Topcon TRC-50DX:
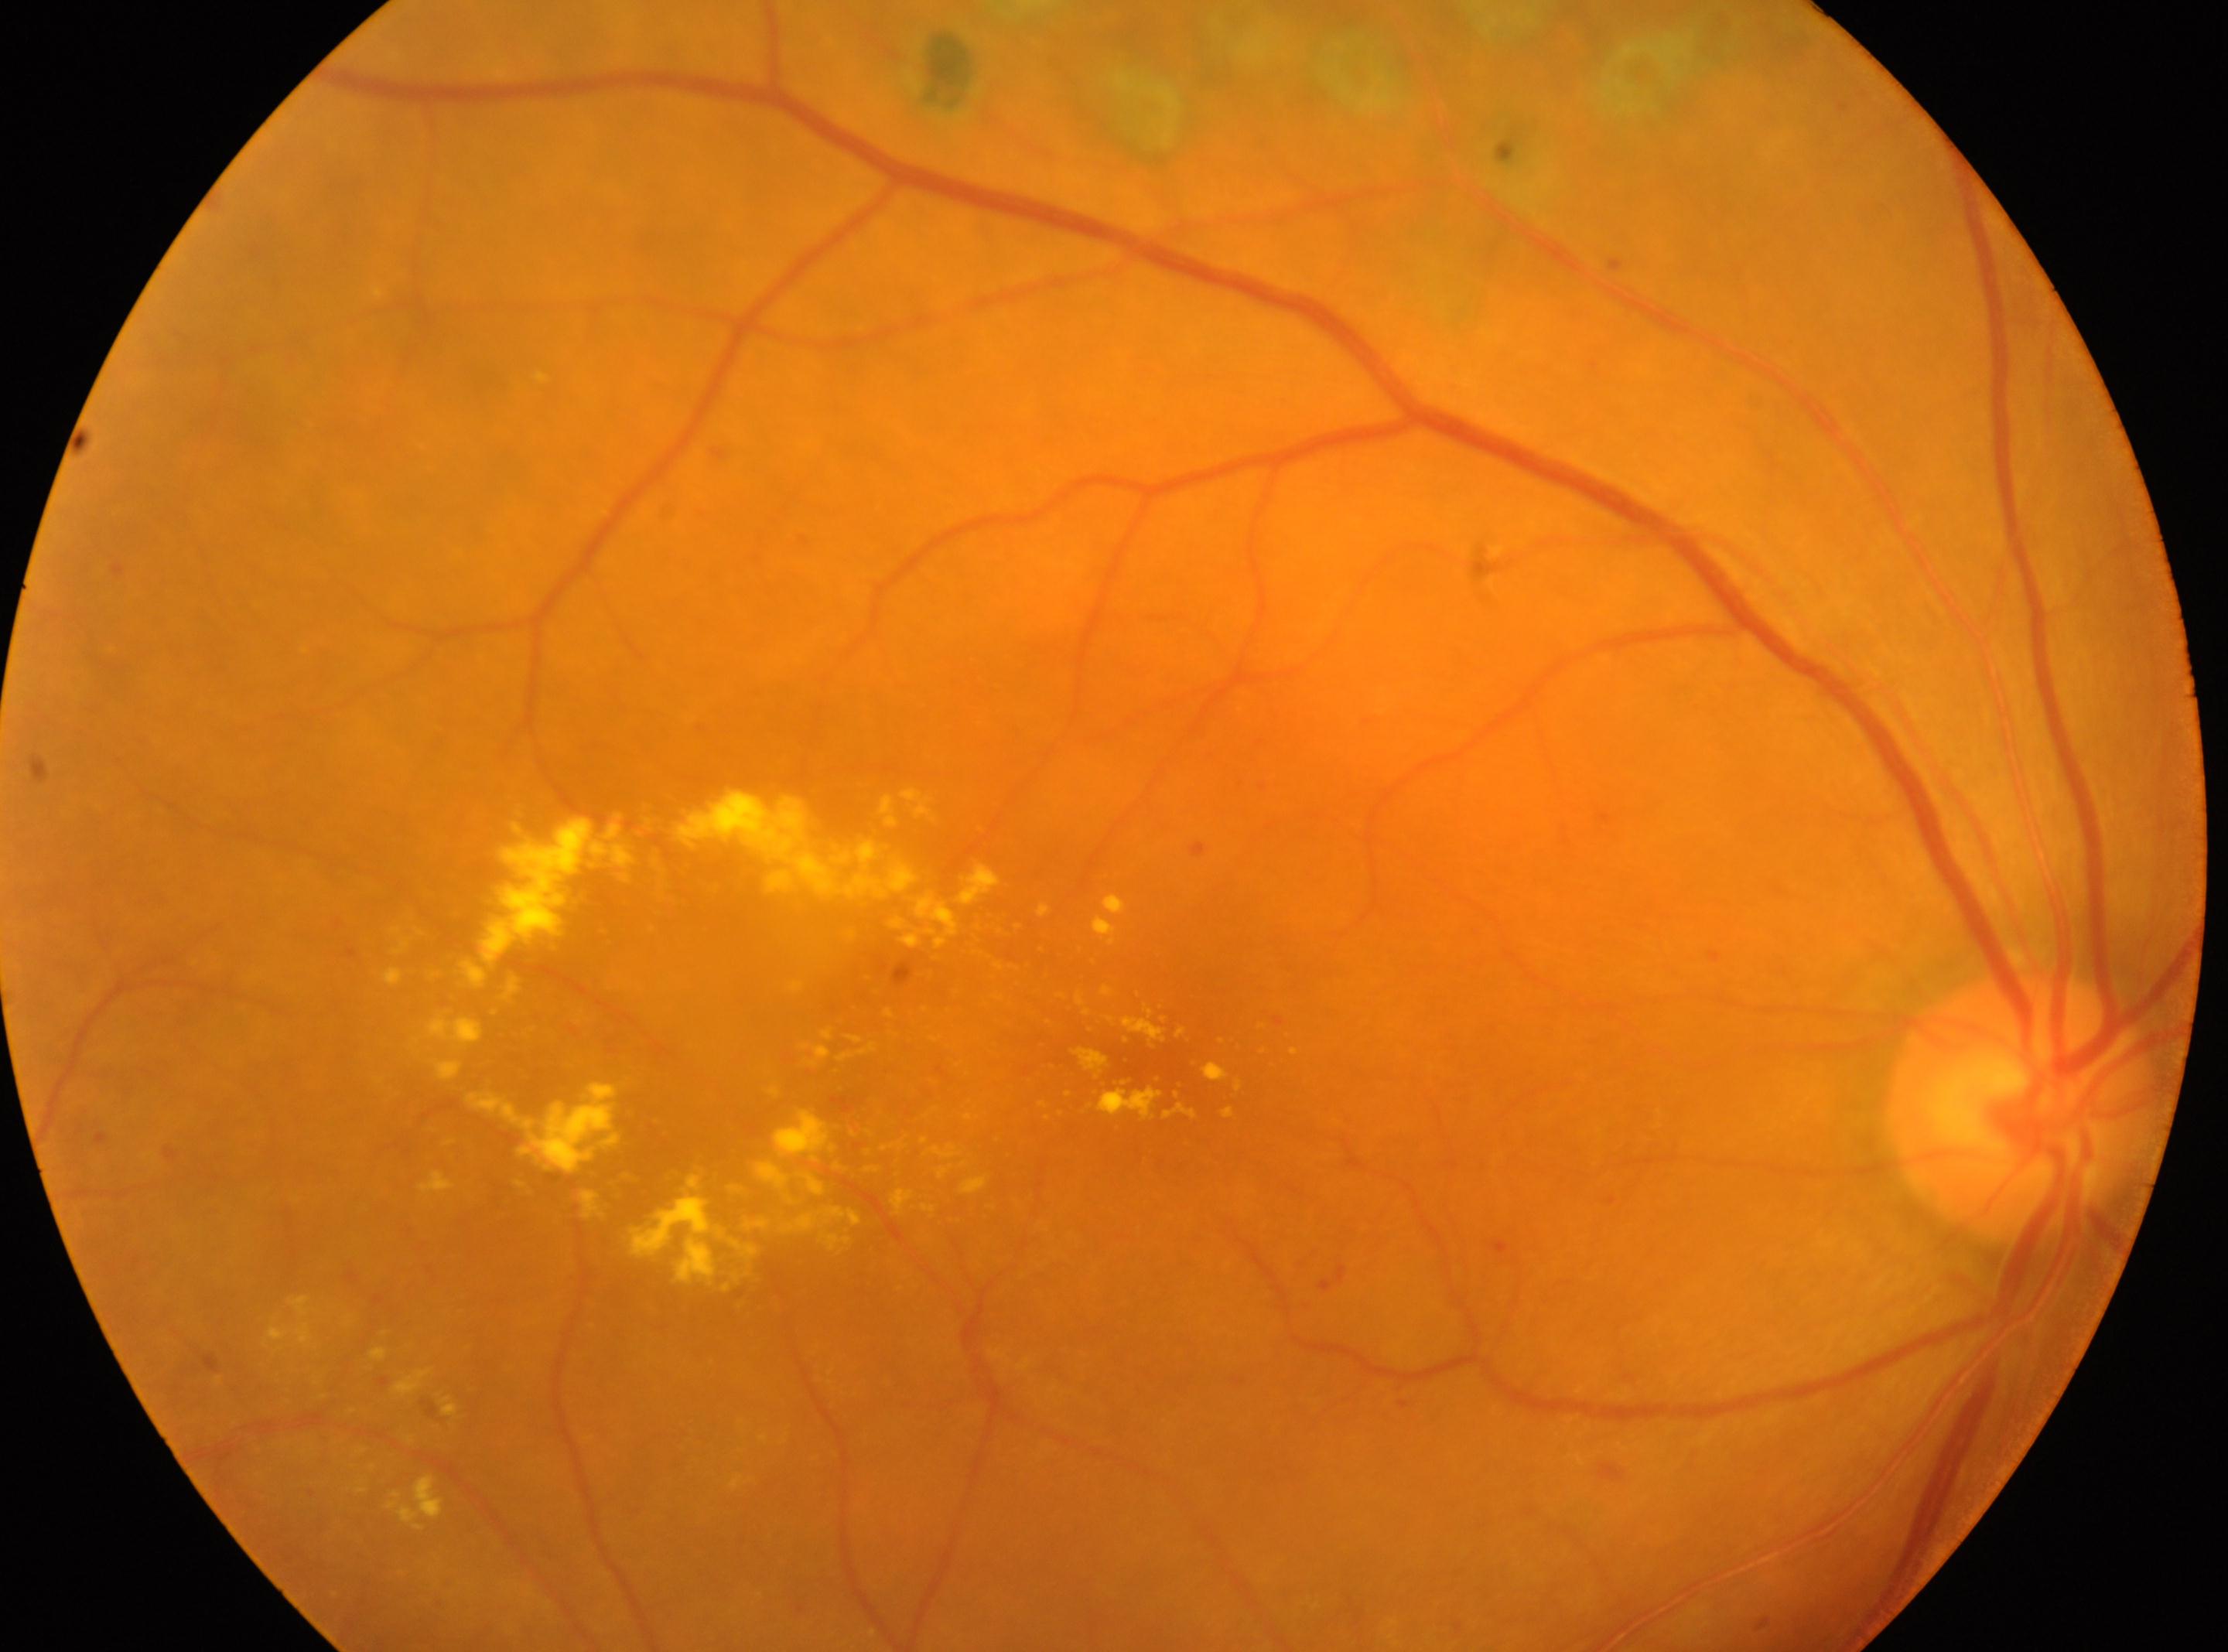

Findings:
– optic disk — 2018, 1107
– fovea centralis — 1160, 1053
– diabetic retinopathy grade — DR with laser spots or scars, underlying severity grade 2 (moderate NPDR)
– laterality — right